Graded on the modified Davis scale, color fundus image
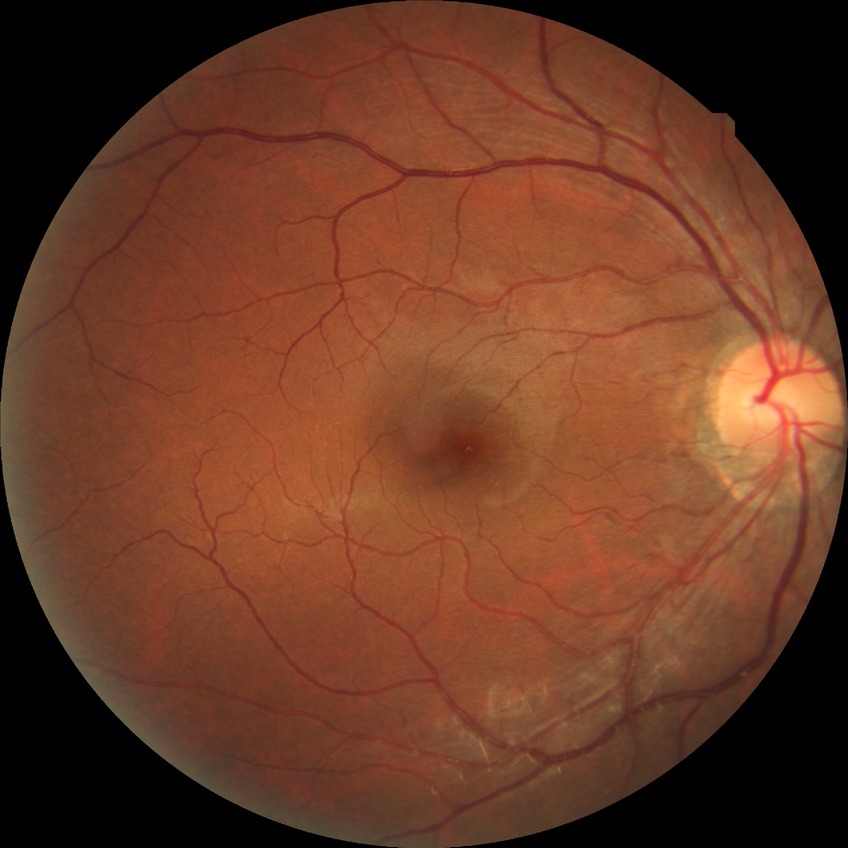

Diabetic retinopathy (DR): no diabetic retinopathy (NDR).